Wide-field fundus image from infant ROP screening; 130° field of view (Clarity RetCam 3)
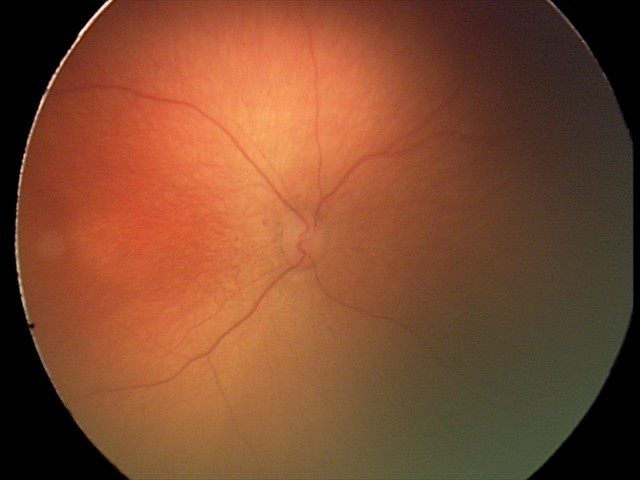

From an examination with diagnosis of retinopathy of prematurity (ROP) stage 1.